Modified Davis classification; no pharmacologic dilation: 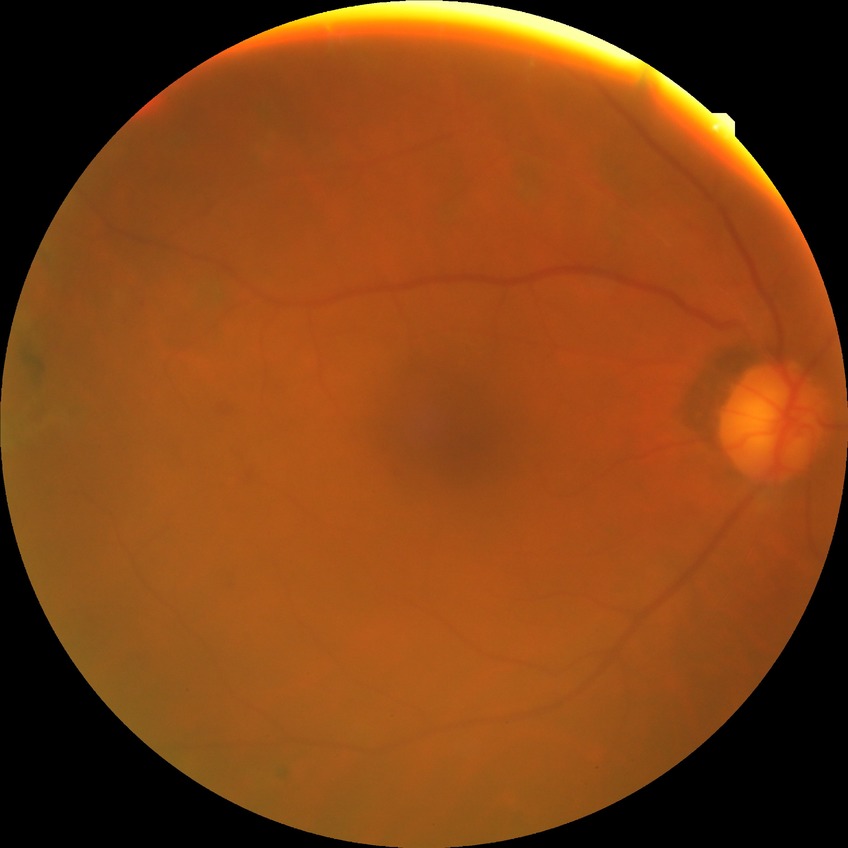 Assessment:
• modified Davis grading: proliferative diabetic retinopathy